Wide-field fundus photograph from neonatal ROP screening · 640 x 480 pixels.
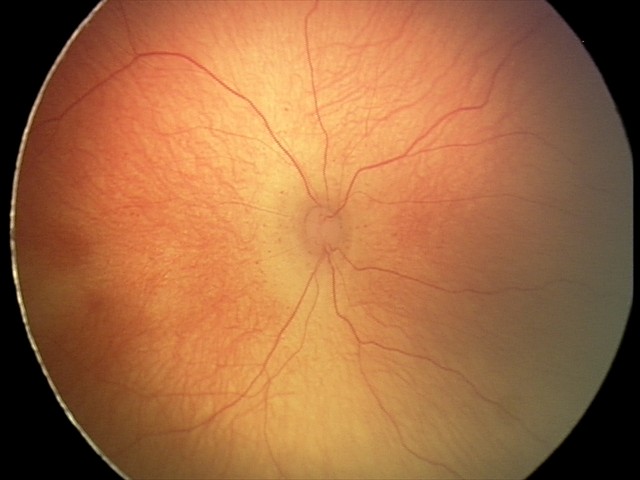

Screening: retinopathy of prematurity stage 2.